Color fundus photograph; 45° FOV
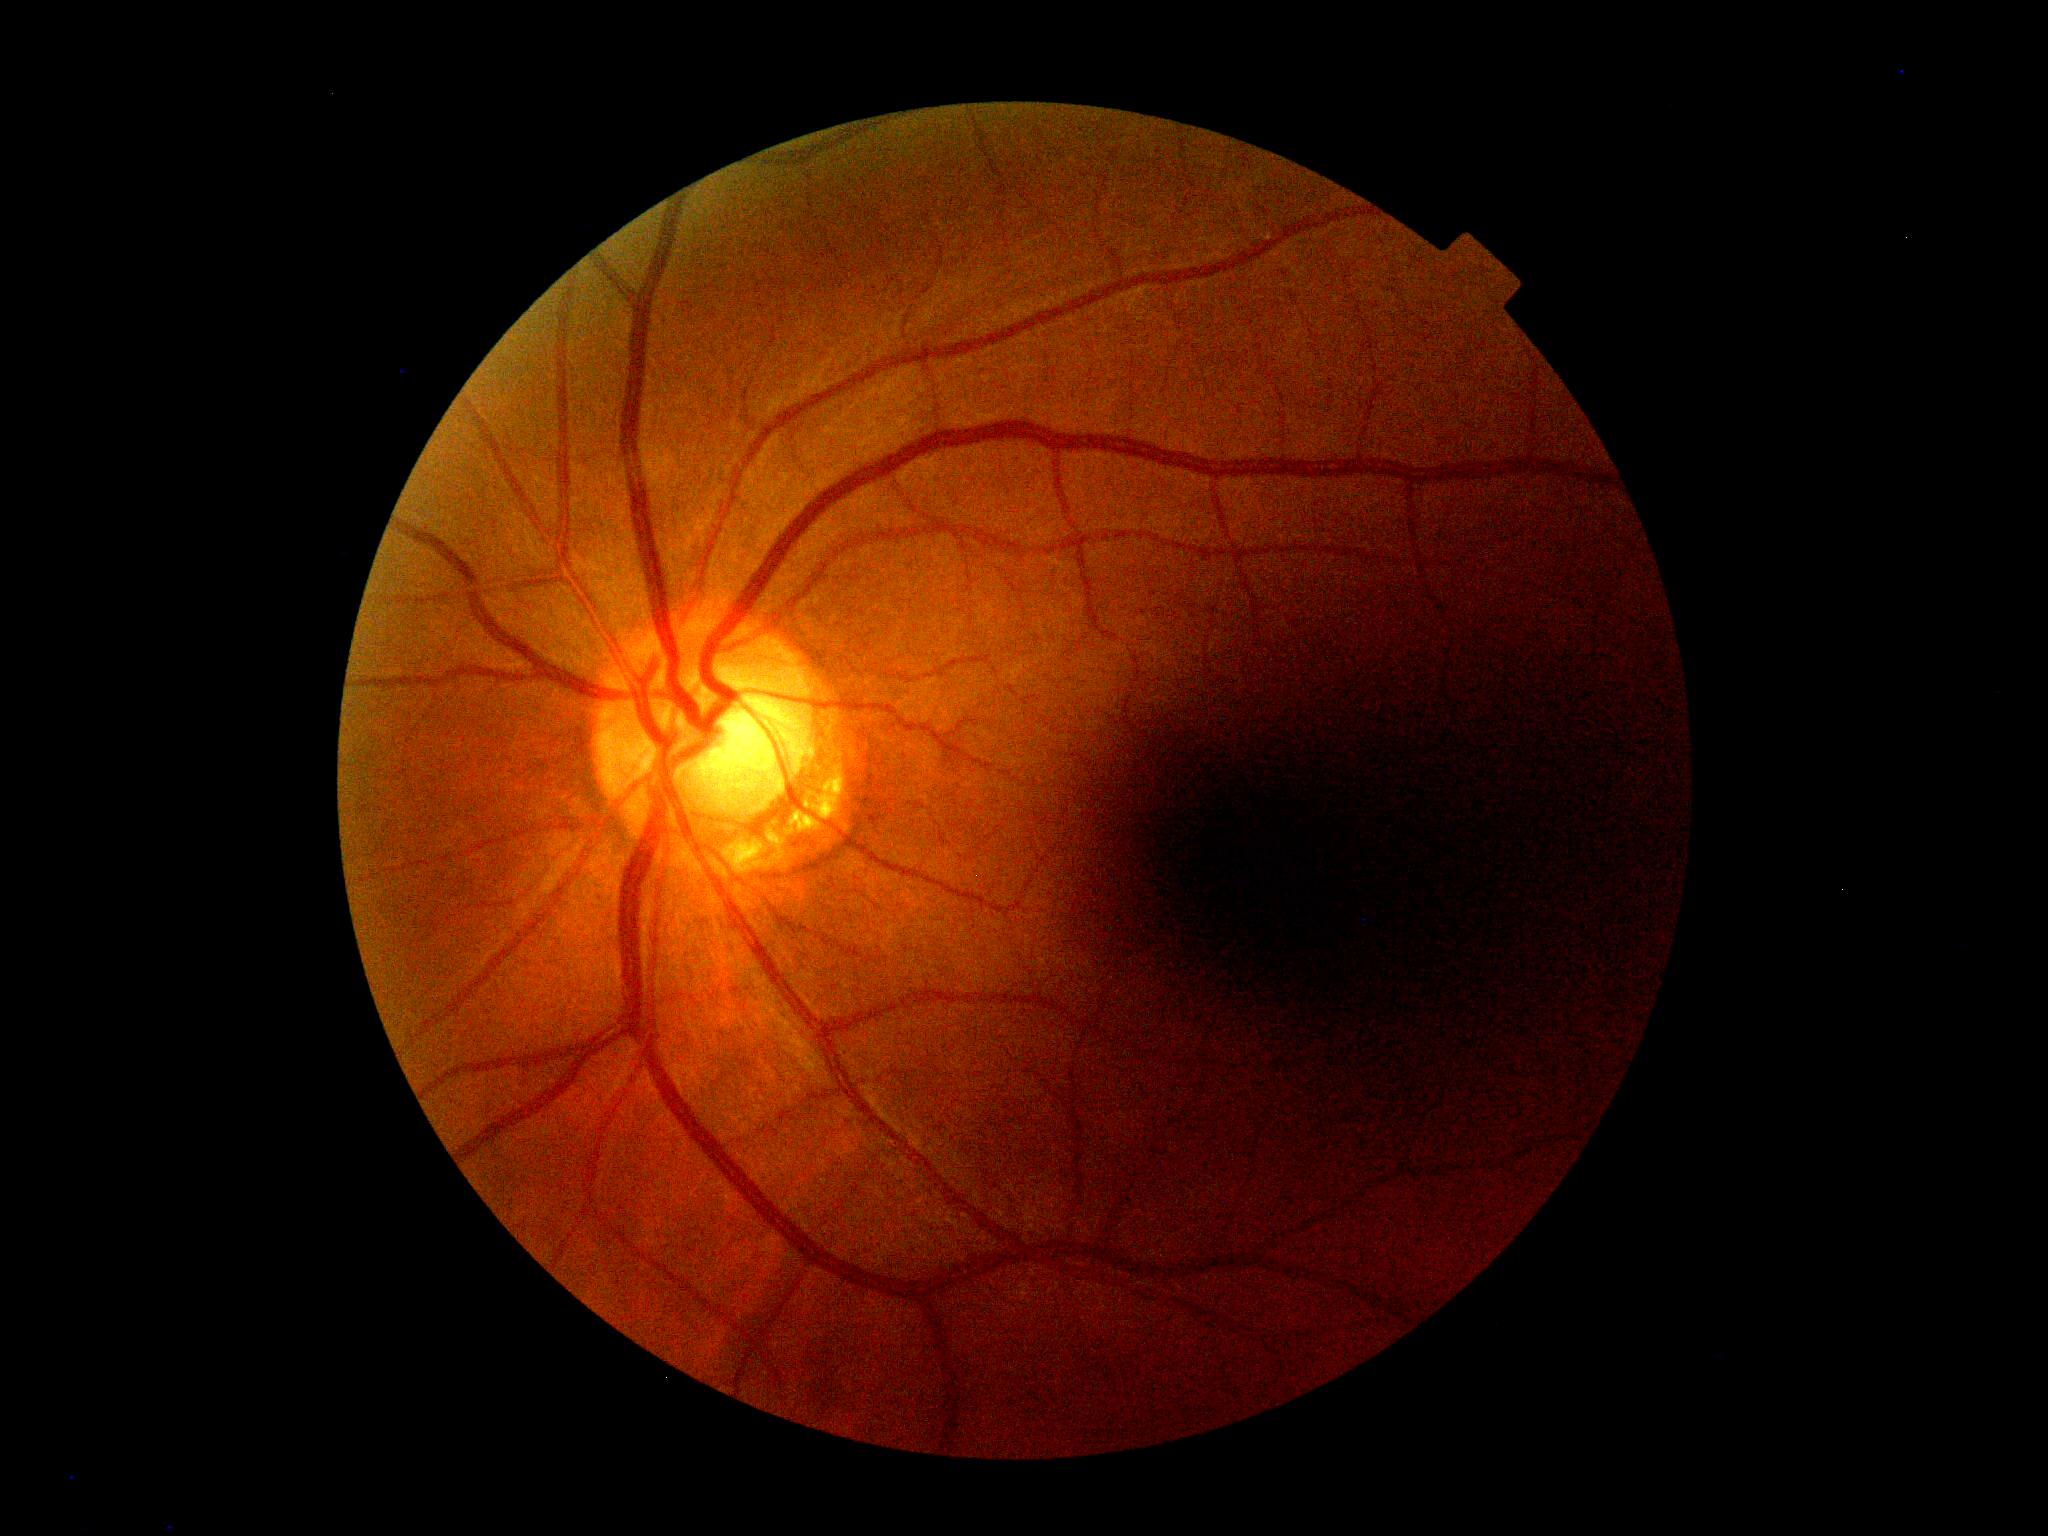

No diabetic retinal disease findings. Diabetic retinopathy (DR): grade 0 (no apparent retinopathy).